Color fundus photograph; 1536 by 1152 pixels; FOV: 45 degrees — 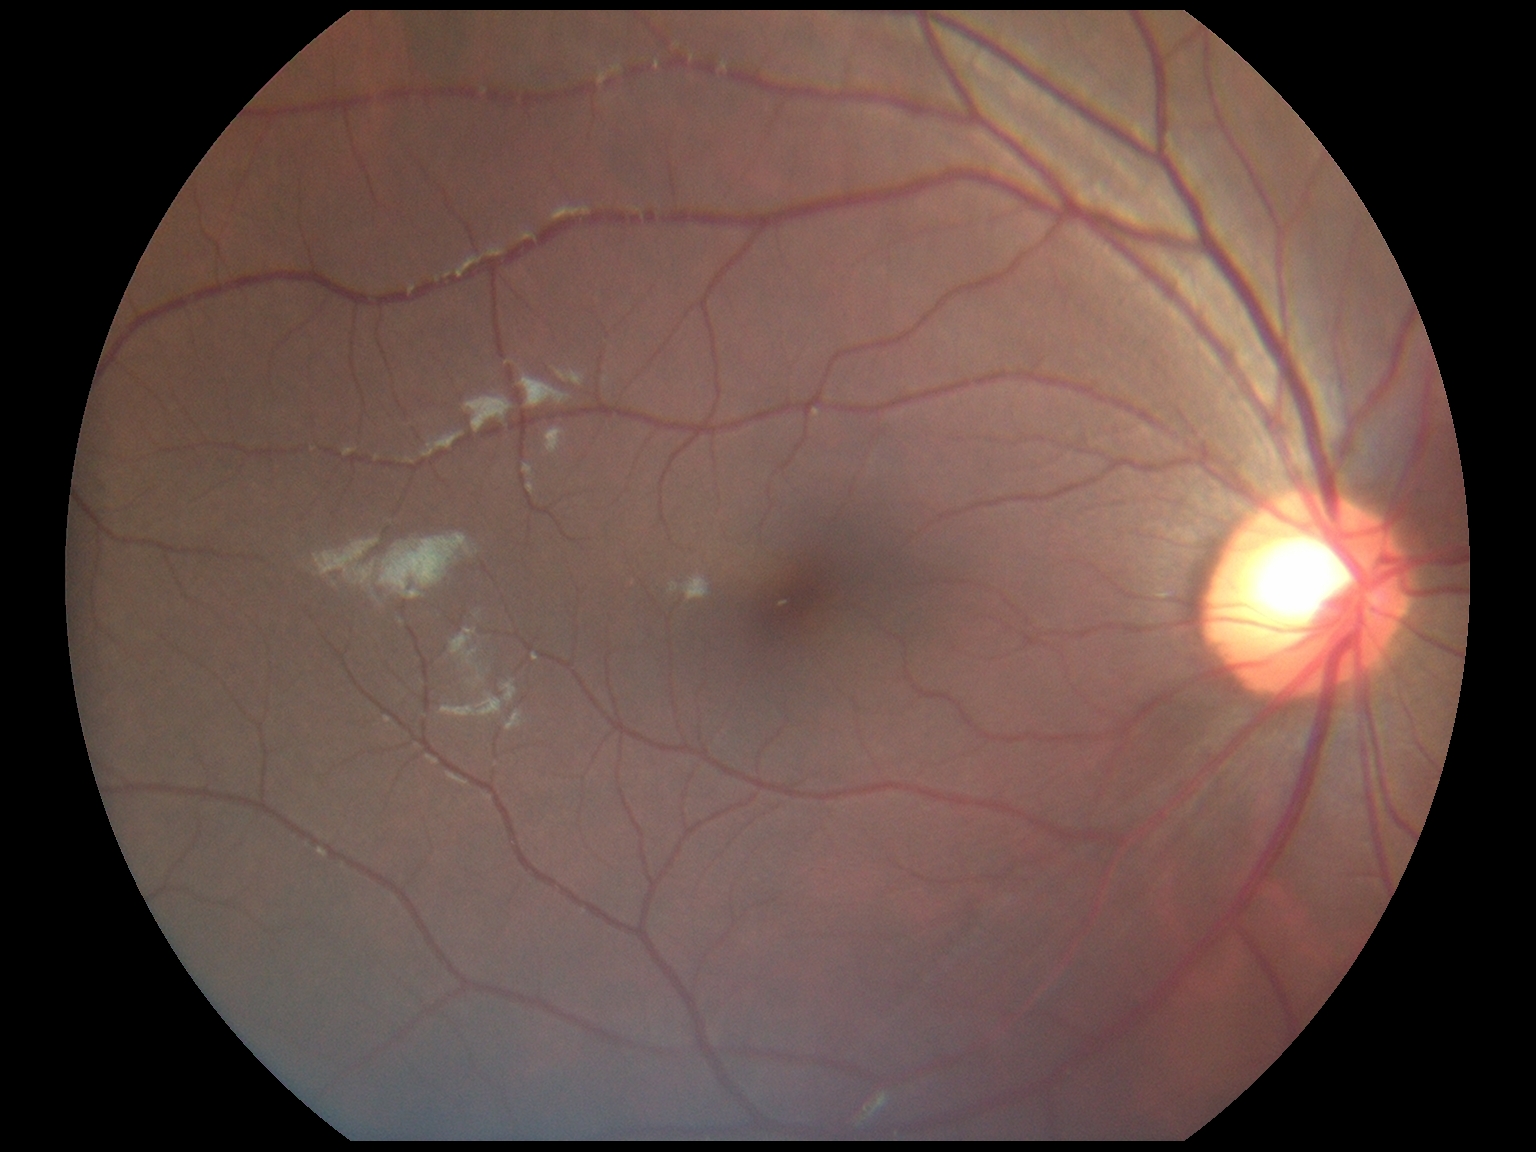 No DR findings. Diabetic retinopathy (DR): 0 — no visible signs of diabetic retinopathy.